Image size 2352x1568. Color fundus image — 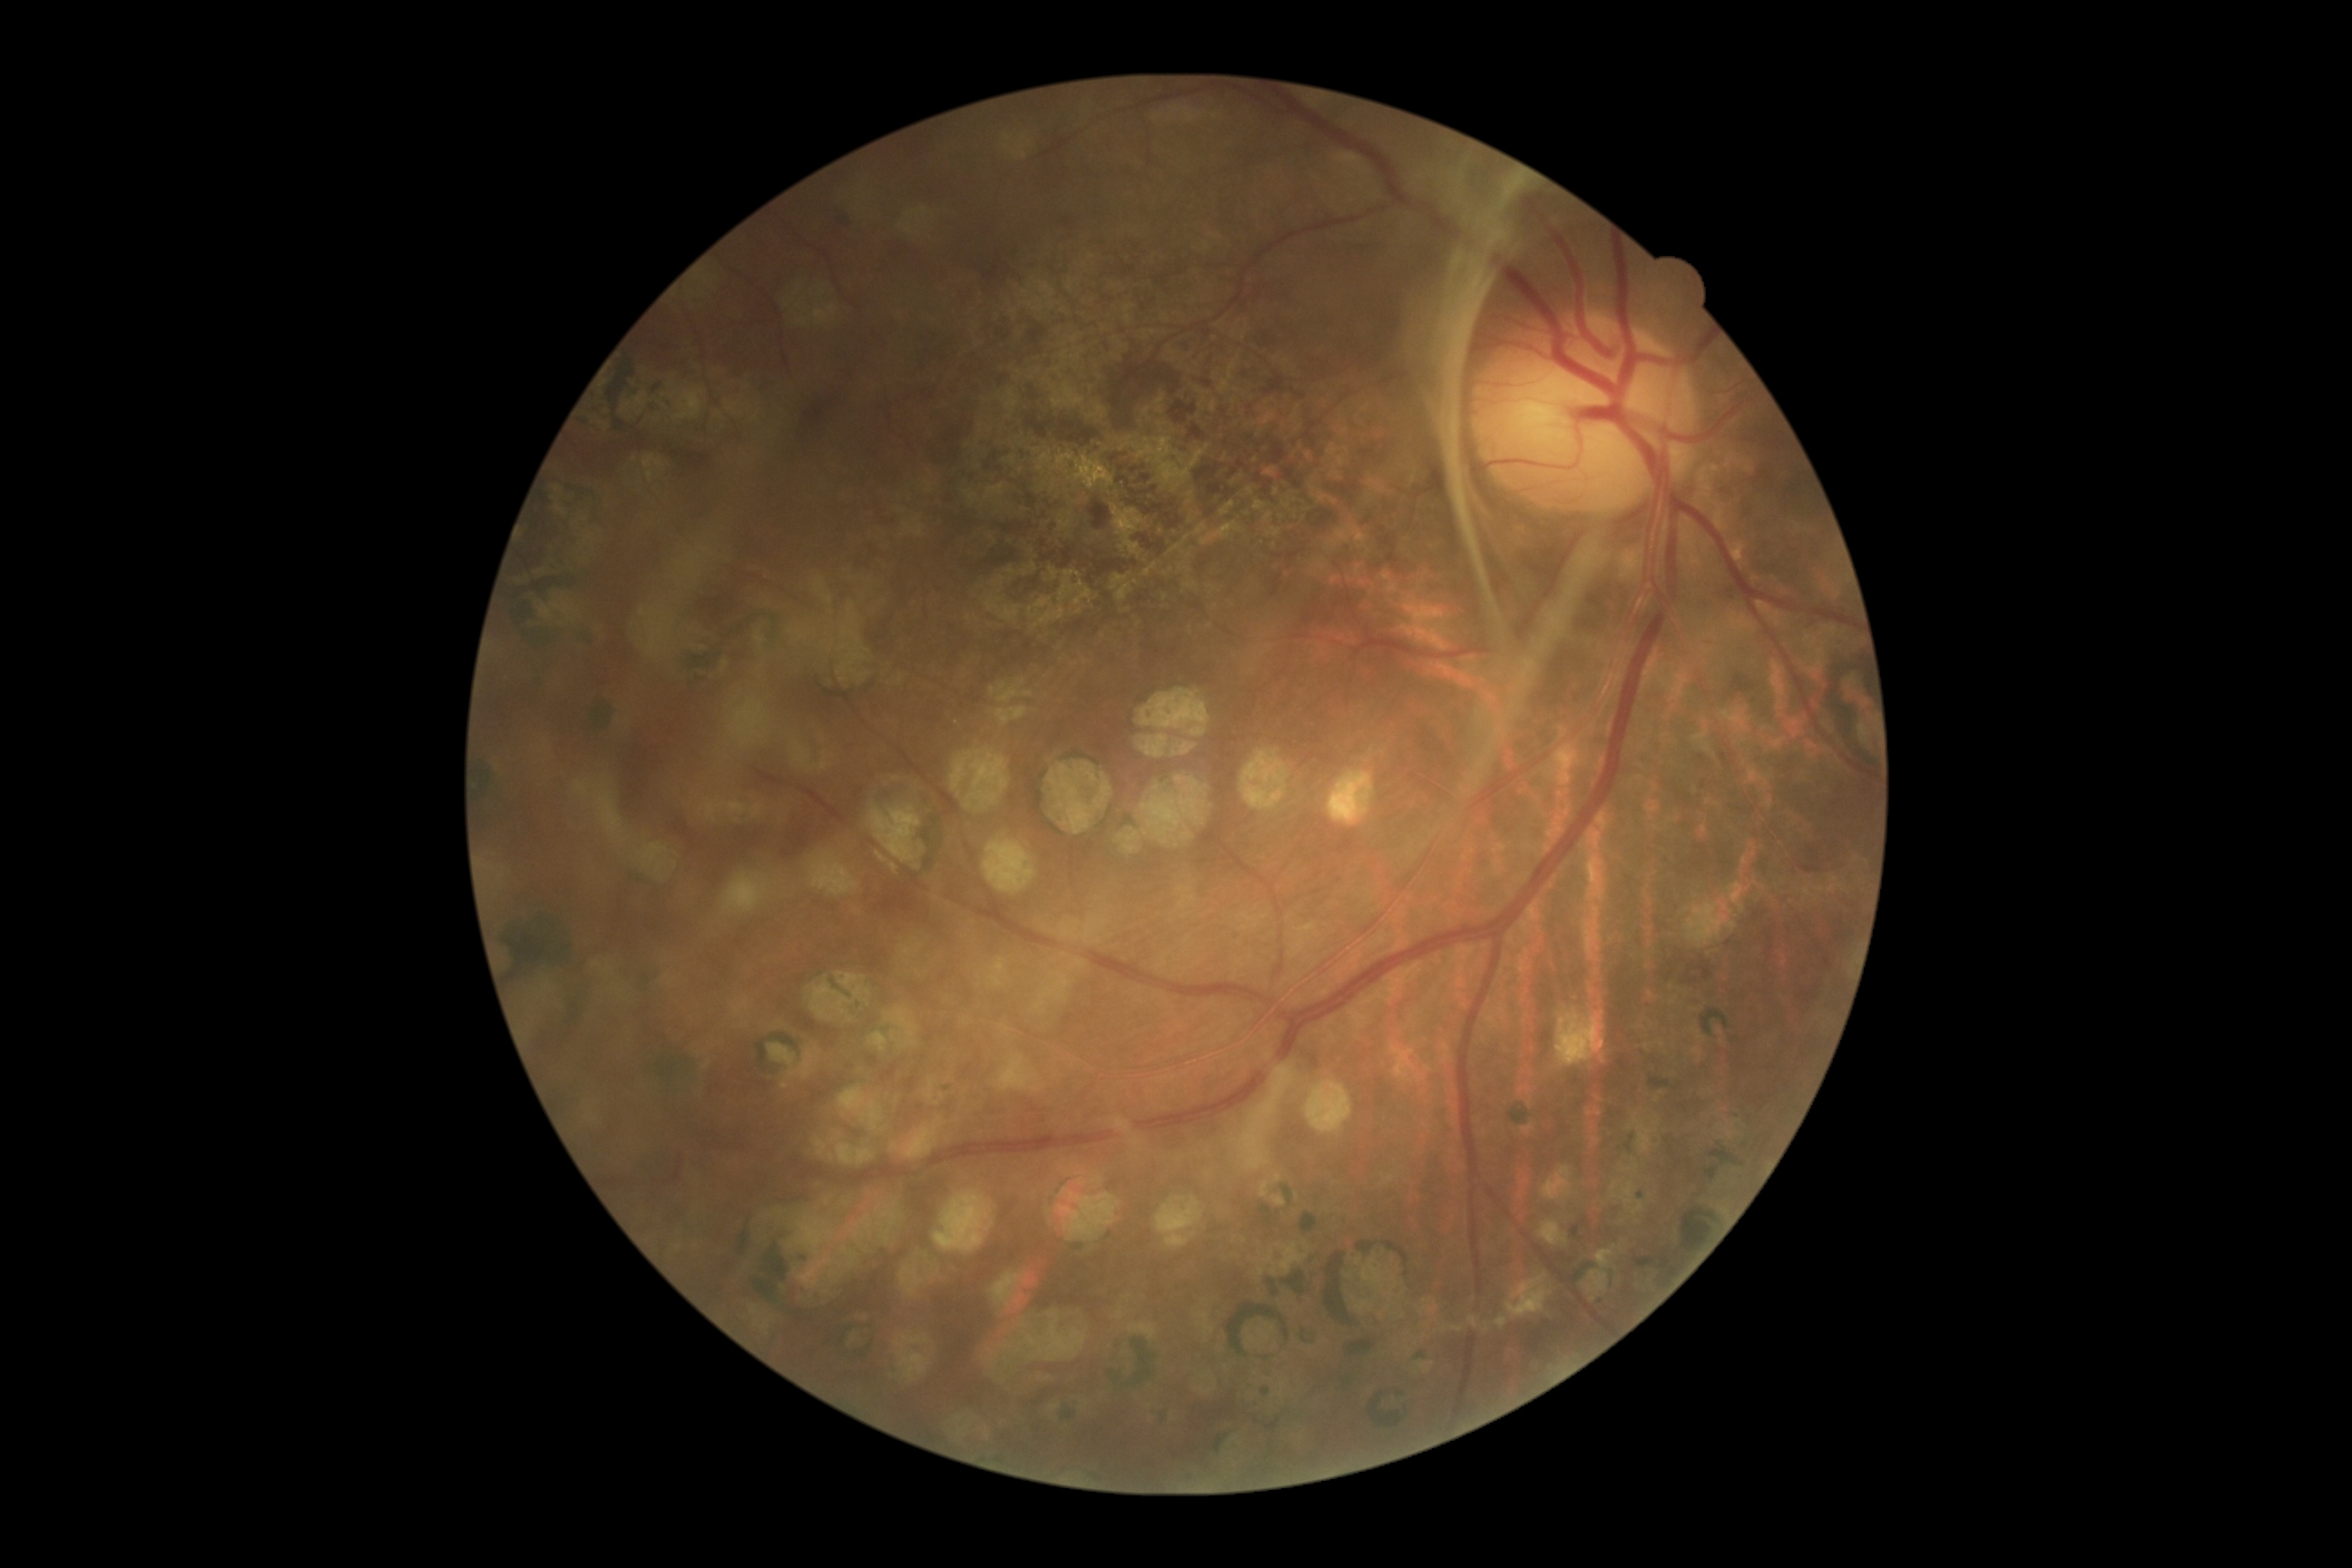
DR stage: grade 4 (PDR) — neovascularization and/or vitreous/pre-retinal hemorrhage.